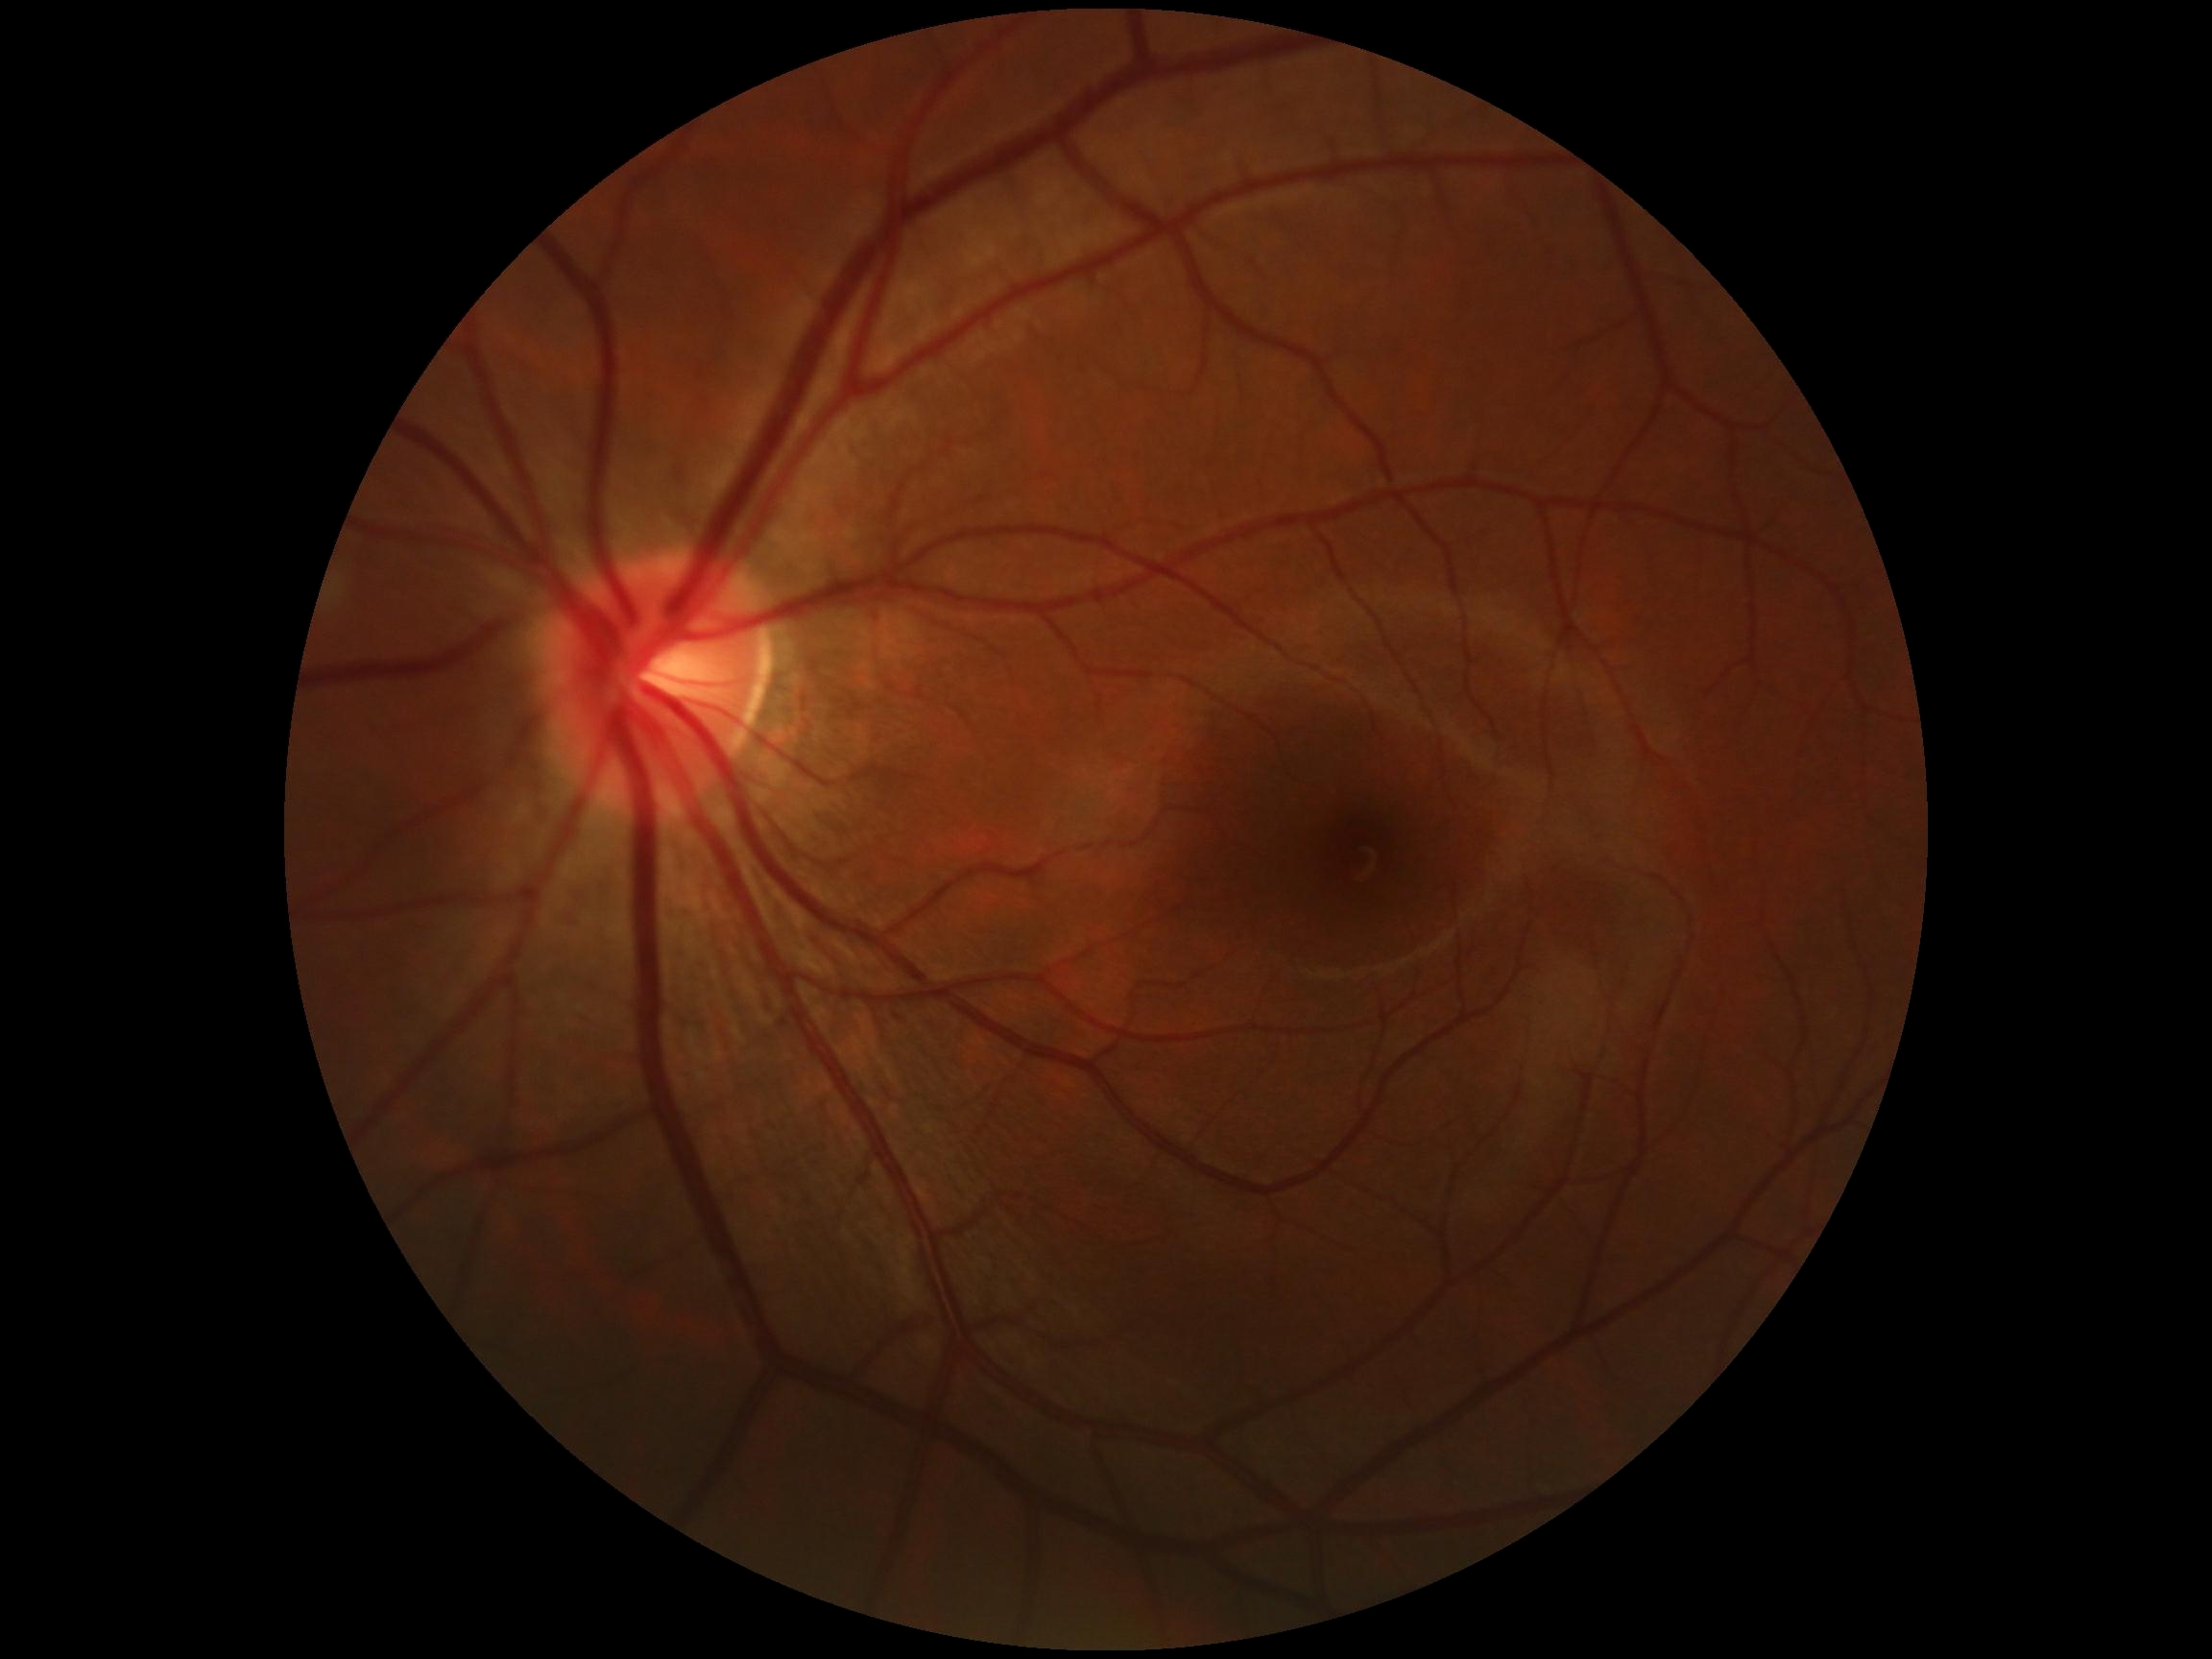
DR impression@no DR findings, retinopathy grade@0 (no apparent retinopathy).